Wide-field fundus photograph from neonatal ROP screening. Natus RetCam Envision, 130° FOV
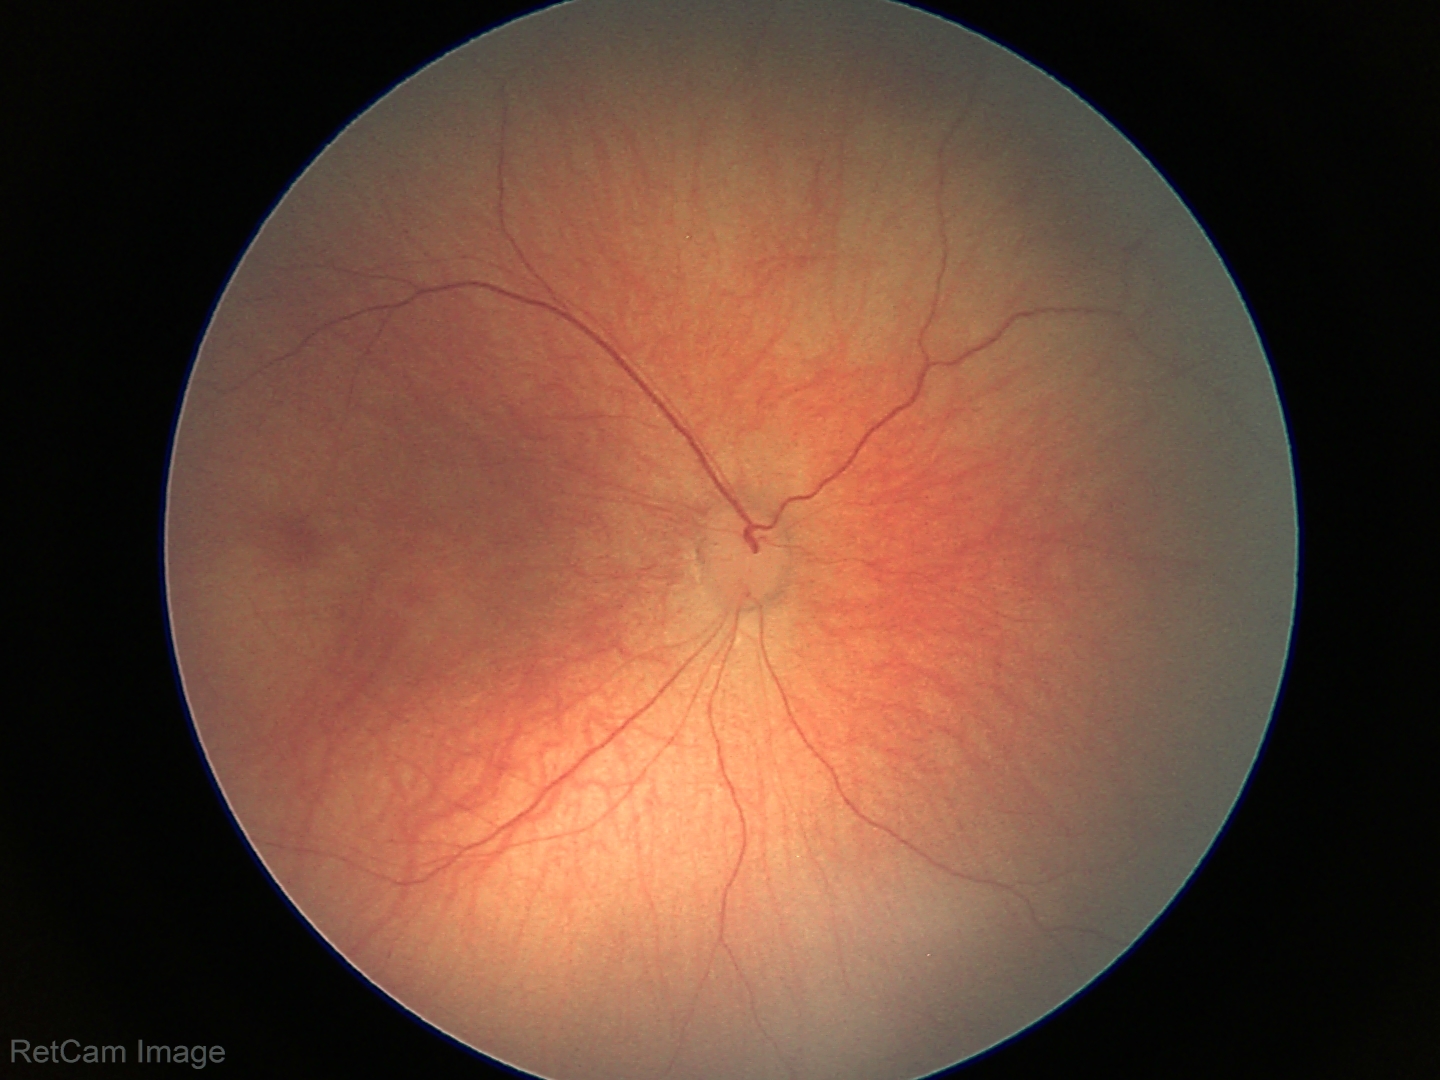

Q: What is the diagnosis from this examination?
A: physiological appearance with no retinal pathology